Color fundus photograph; 45° field of view.
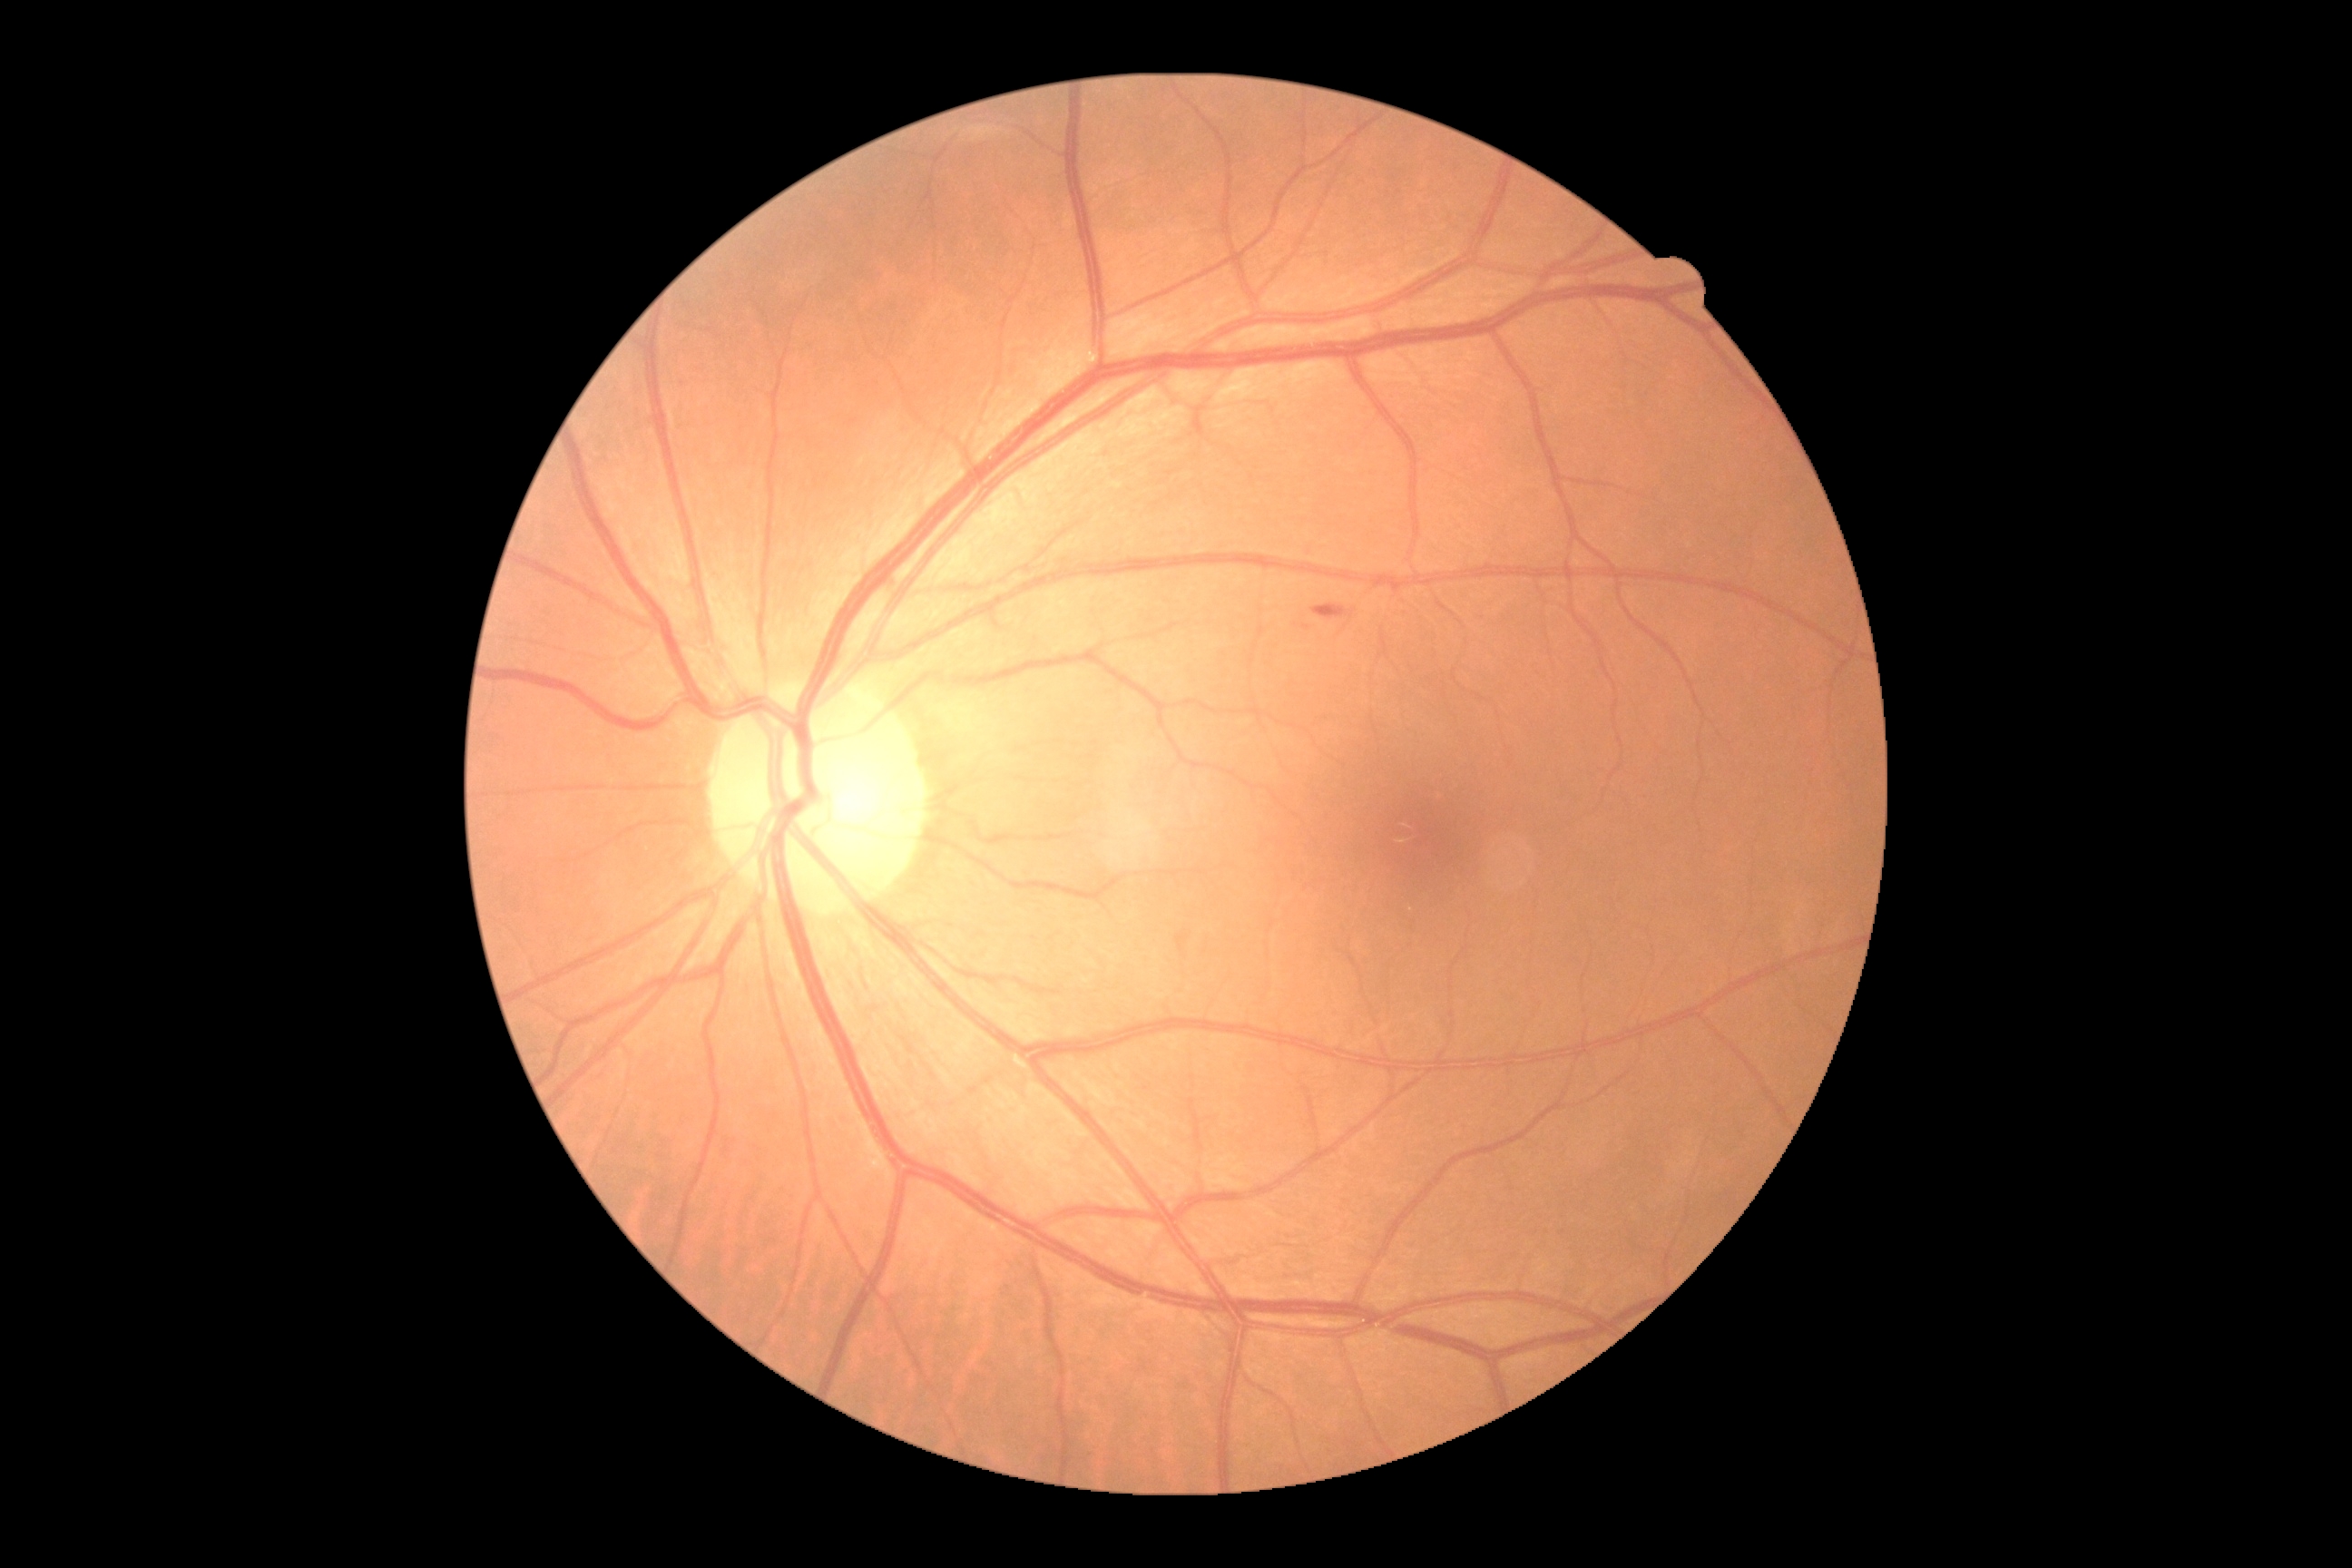 DR severity is moderate NPDR (grade 2).